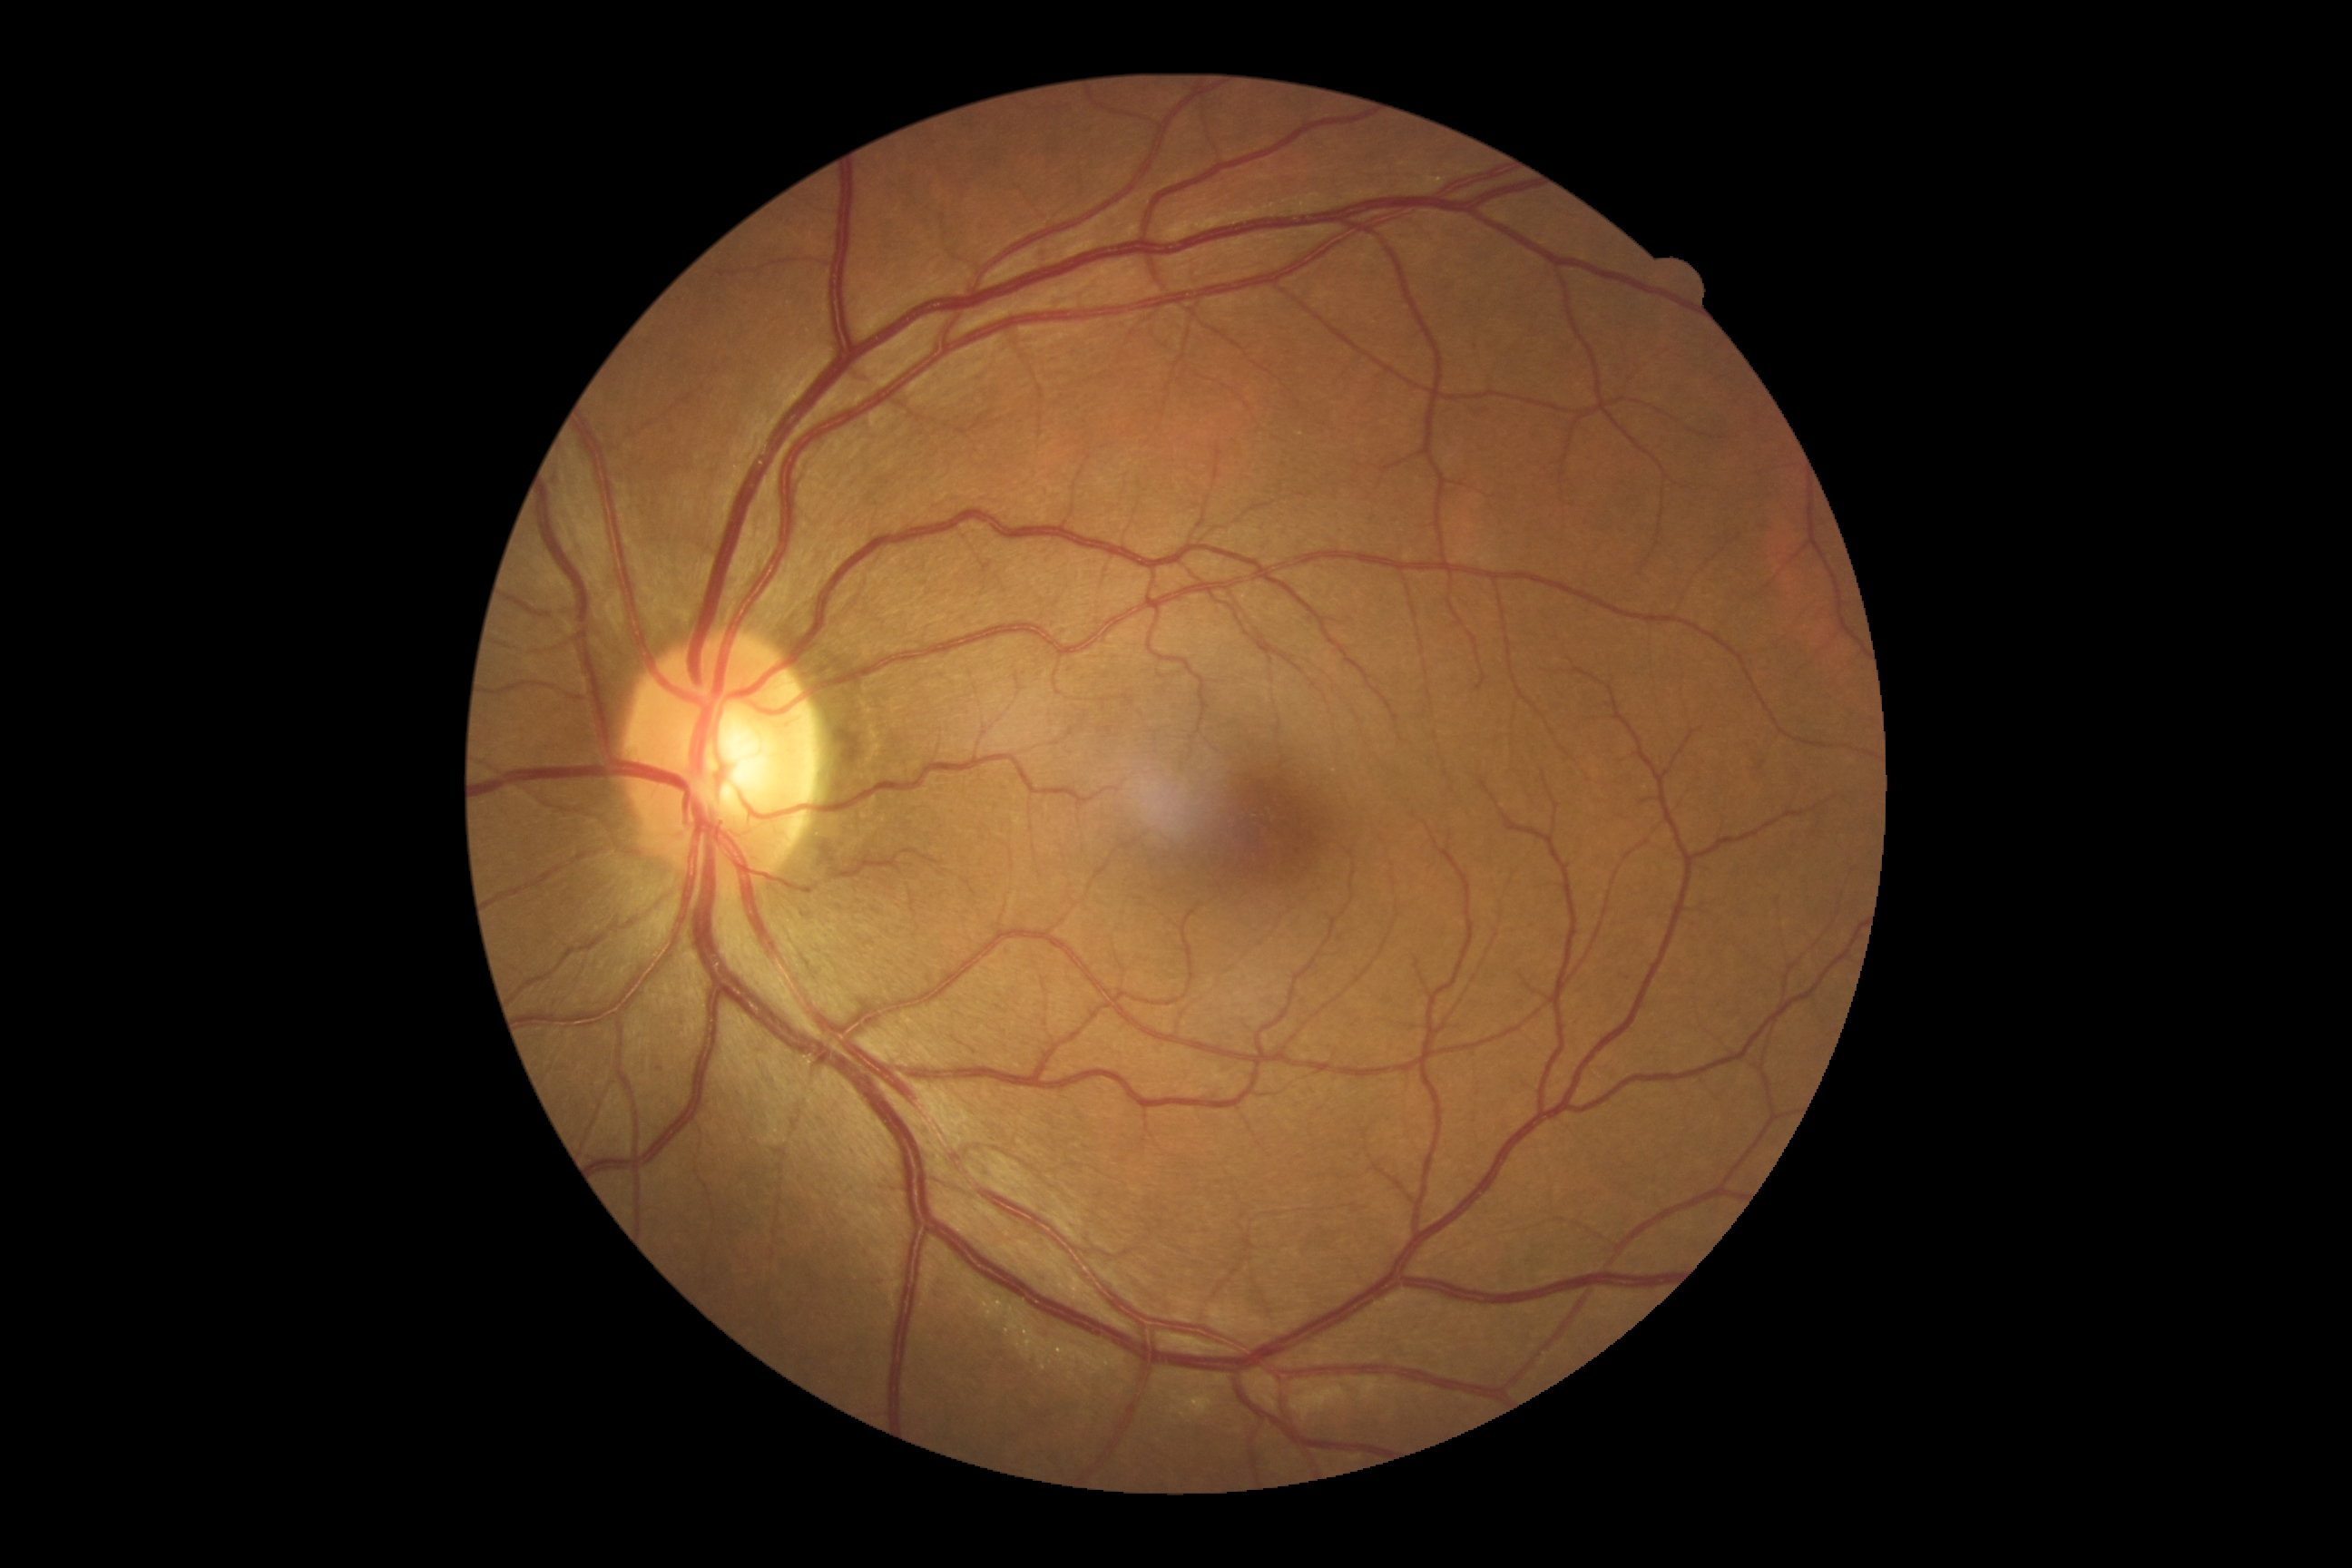
dr_grade: 0/4